DR severity per modified Davis staging: 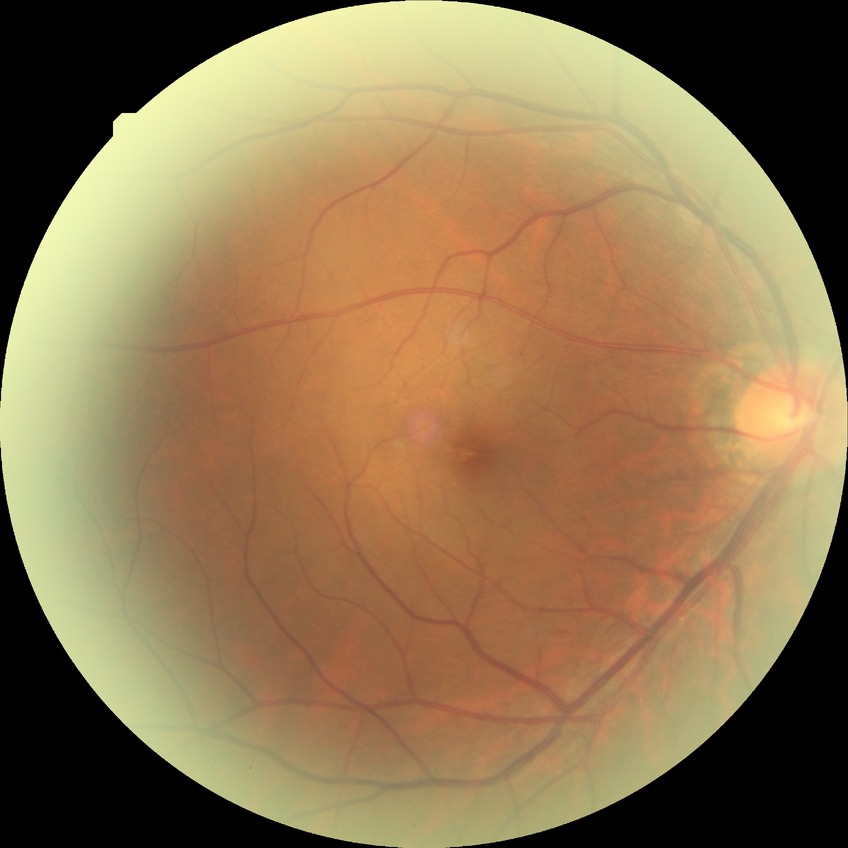
Diabetic retinopathy (DR) is simple diabetic retinopathy (SDR).